1932x1932:
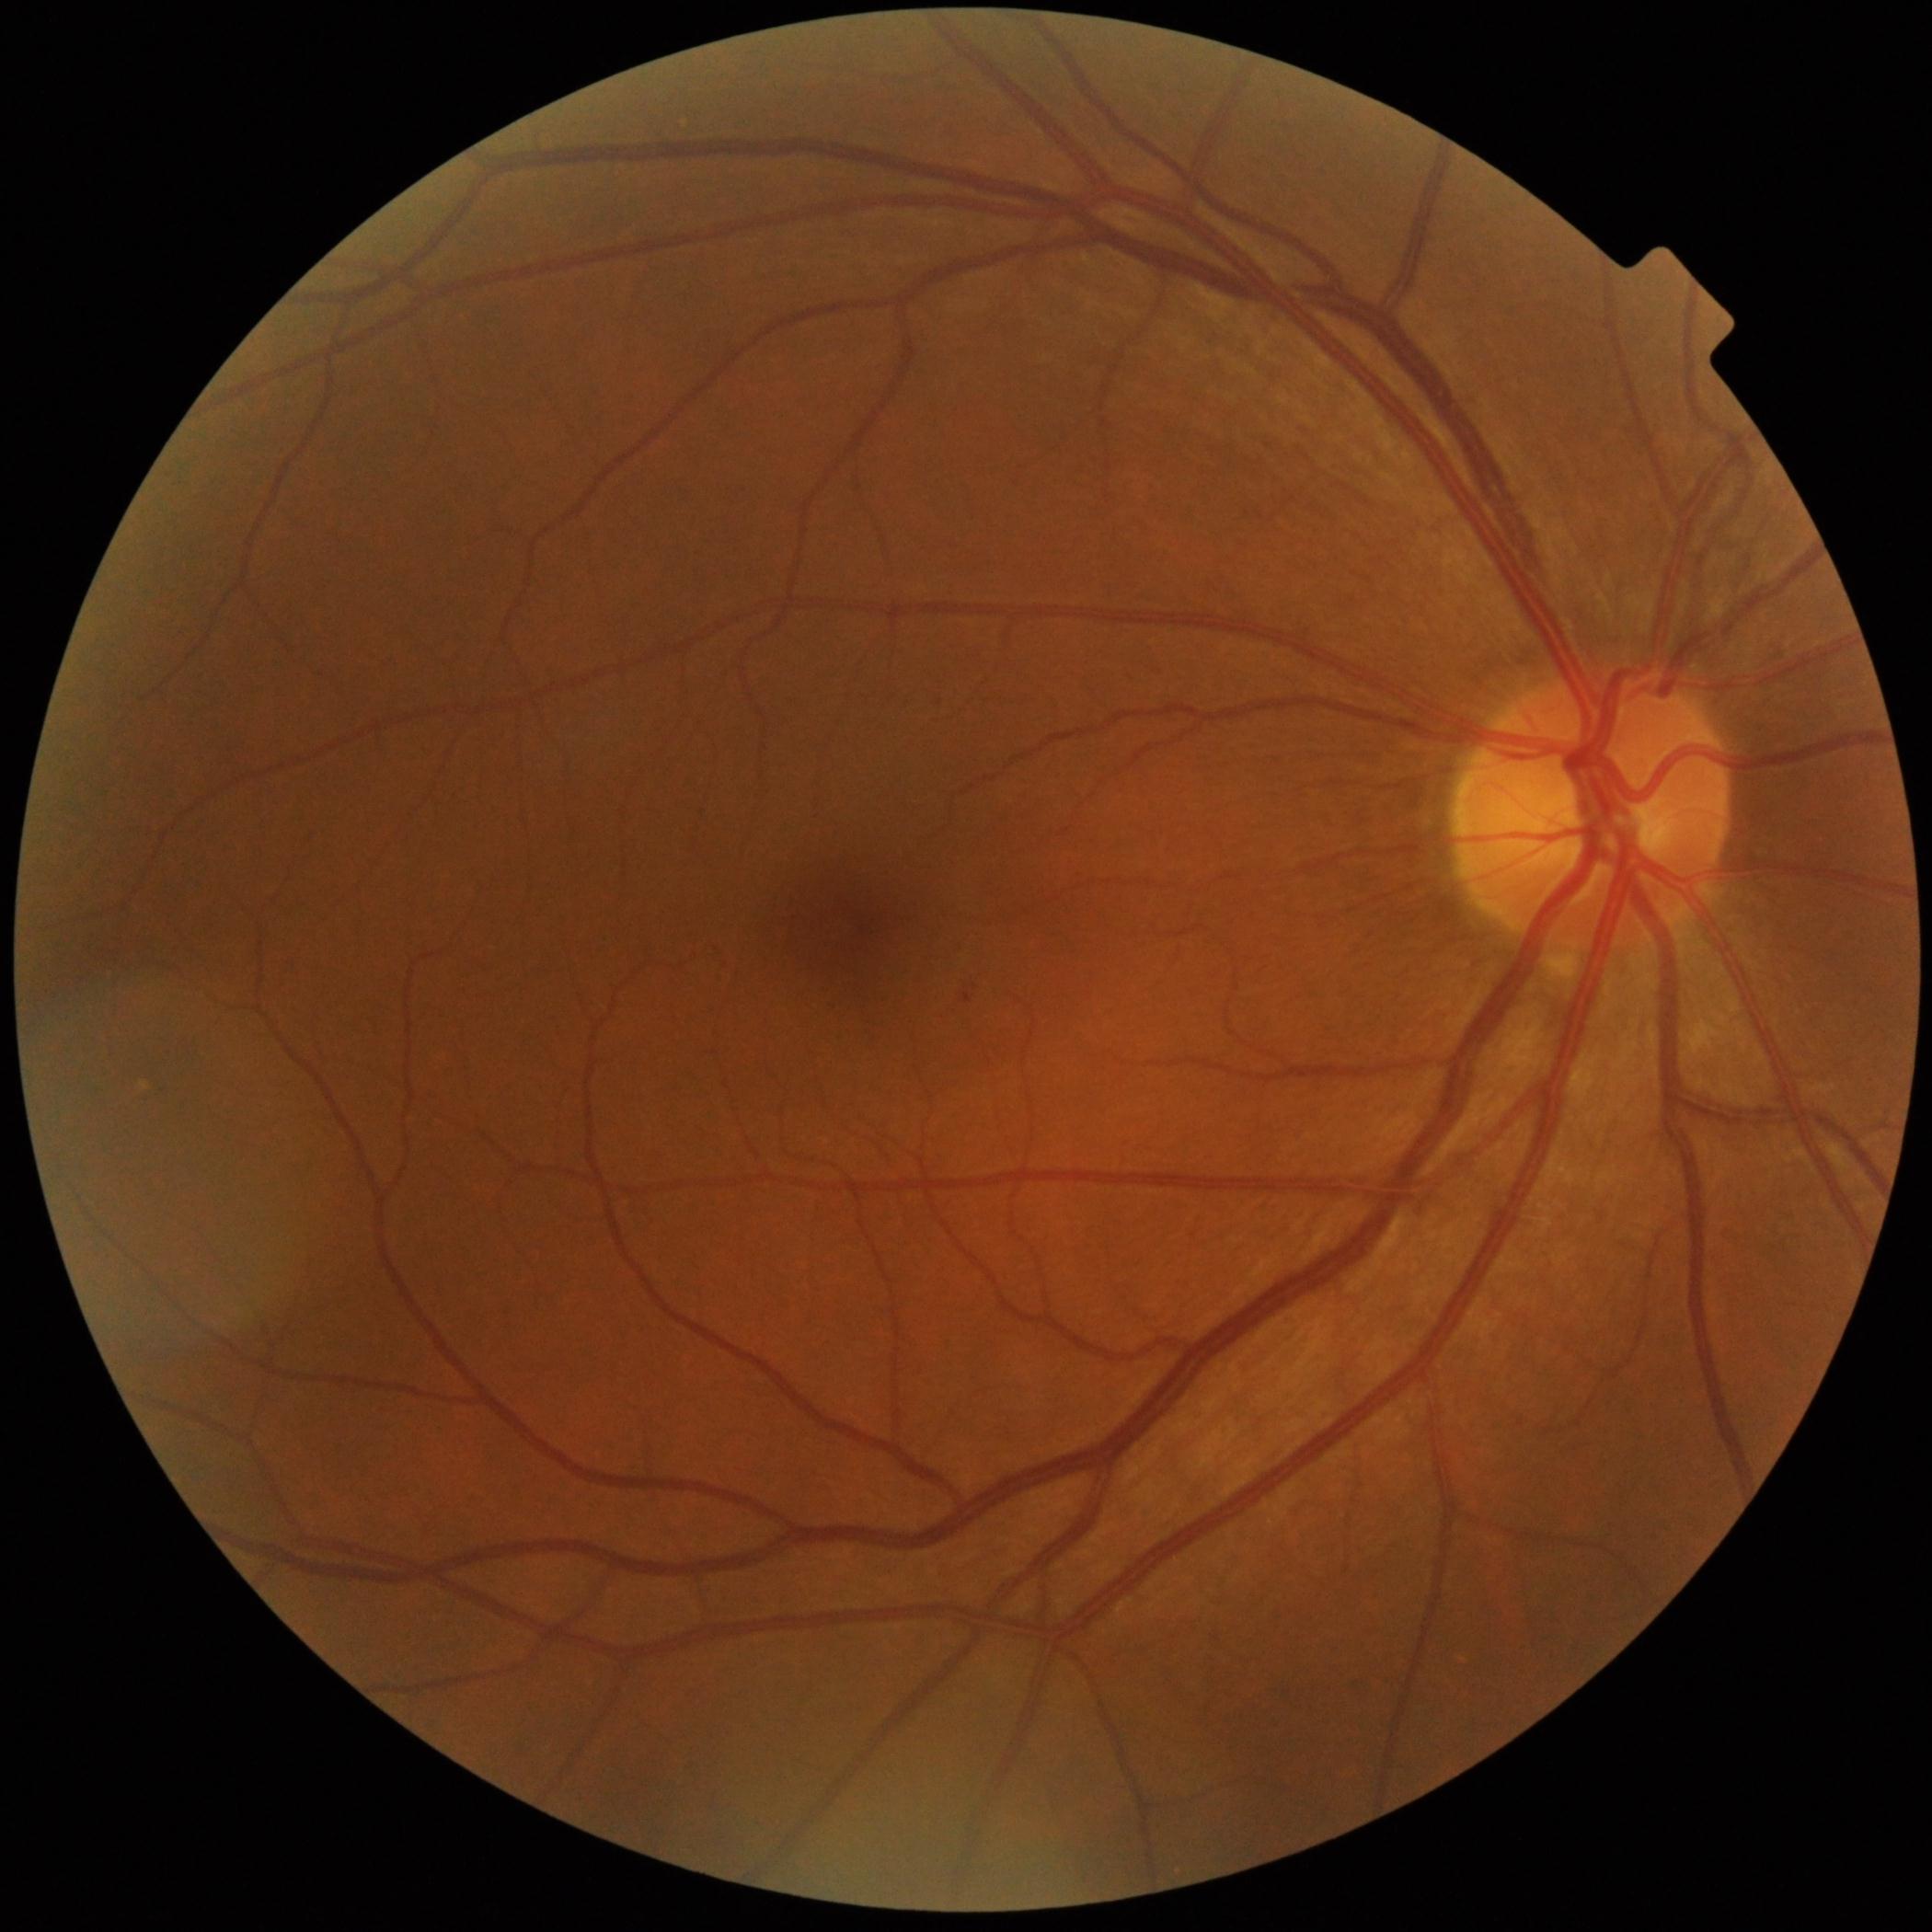
DR = grade 1 (mild NPDR); DR class = non-proliferative diabetic retinopathy.